CFP:
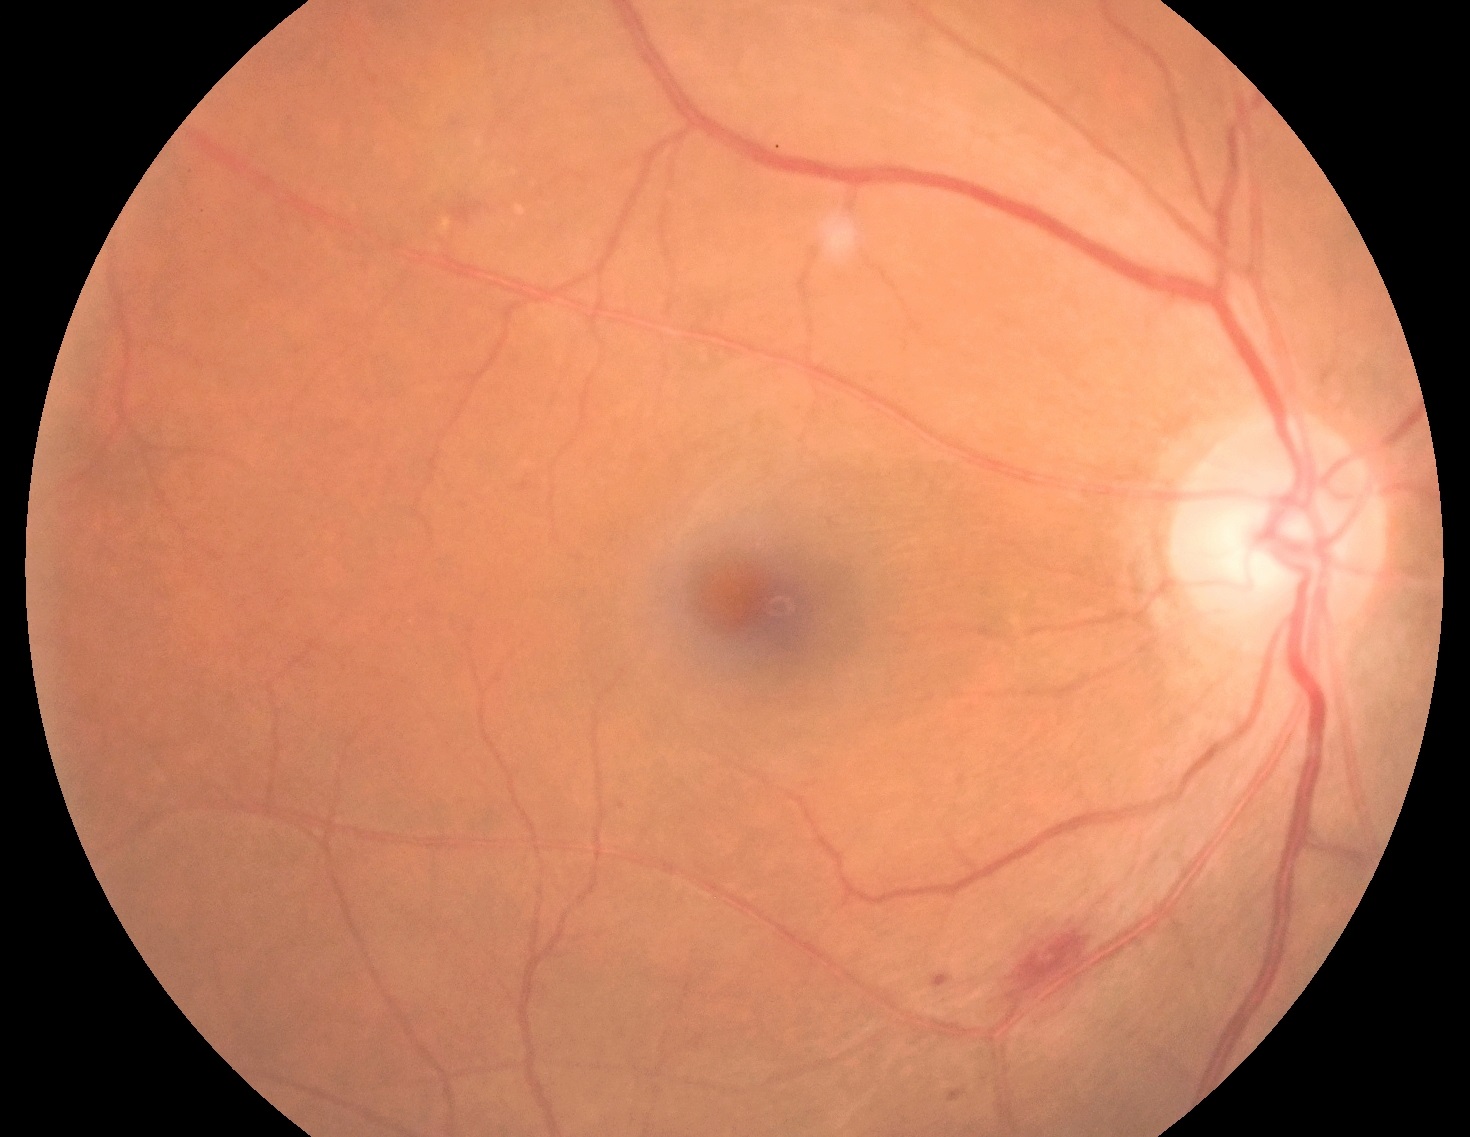
{
  "dr_grade": "2/4"
}